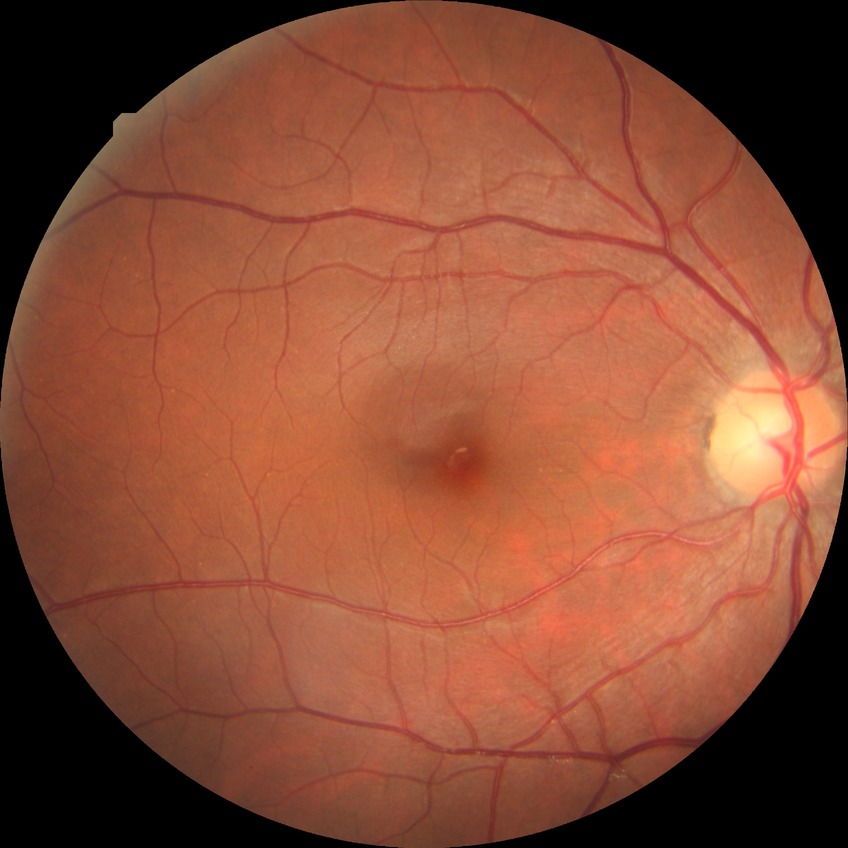

Diabetic retinopathy (DR): NDR (no diabetic retinopathy).